Color fundus image
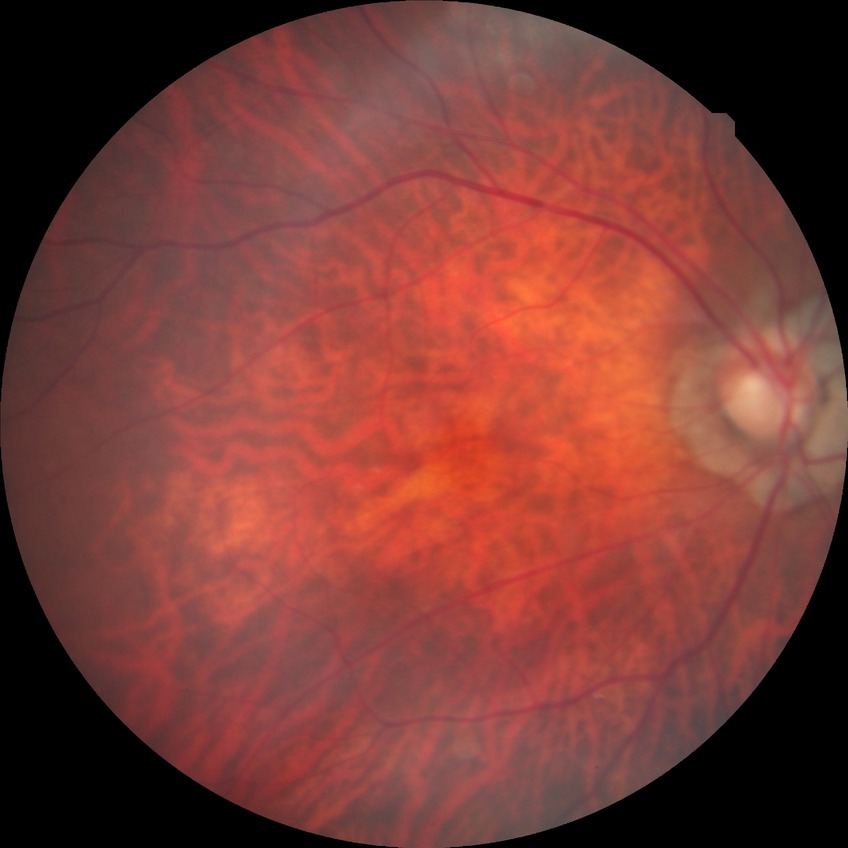
No diabetic retinal disease findings. Davis grade is NDR.